640x480px; pediatric wide-field fundus photograph — 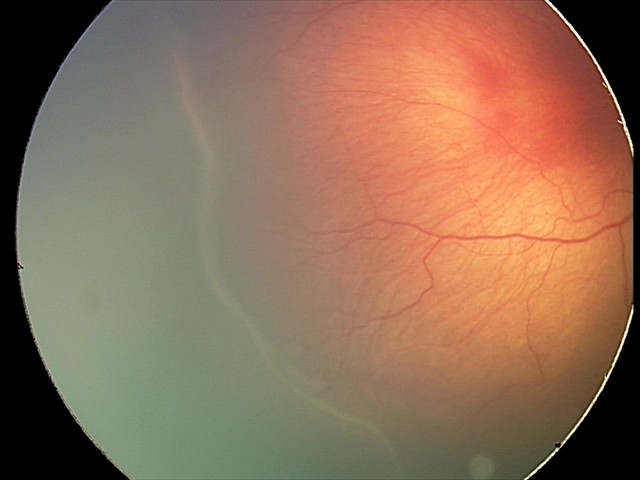
Examination diagnosed as ROP stage 2 — ridge with height and width at the demarcation line.